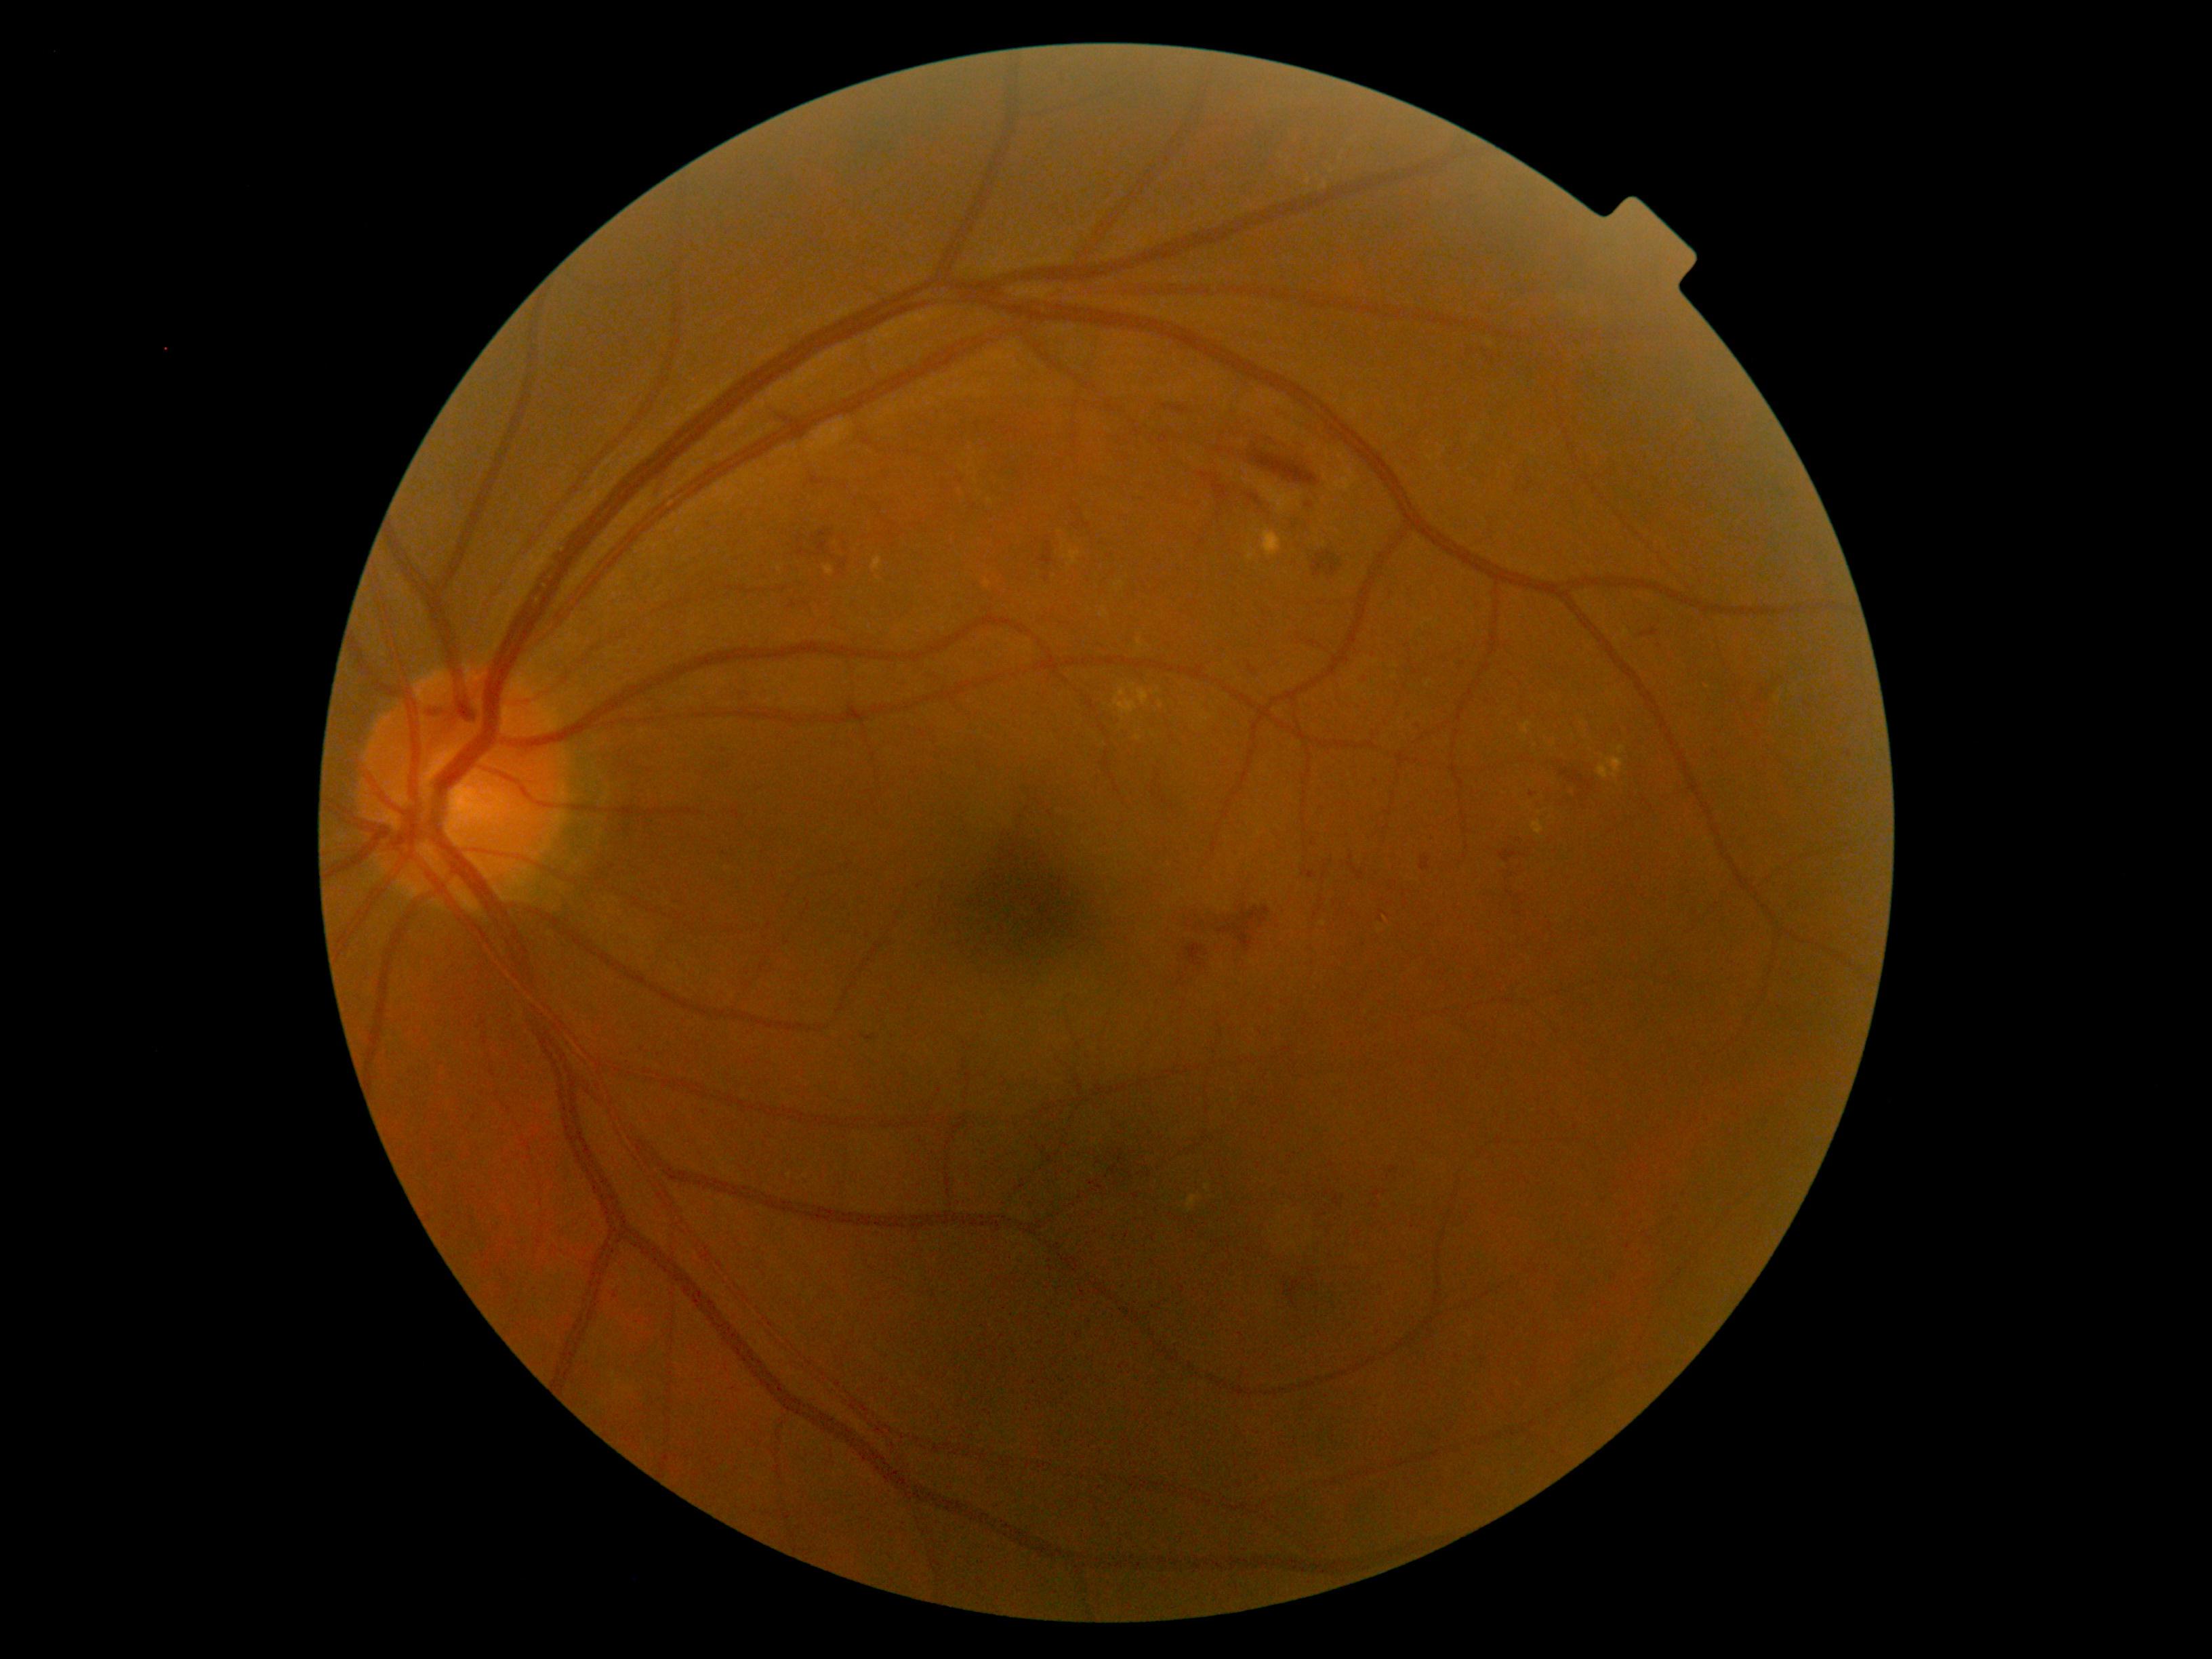
Diabetic retinopathy (DR) is grade 2
Lesions identified (partial list):
hard exudates (EXs) = (1261, 528, 1282, 558); (823, 566, 834, 577); (1113, 689, 1138, 716); (1618, 746, 1626, 754); (1138, 689, 1149, 705); (1523, 723, 1531, 735); (1188, 1196, 1199, 1212); (1531, 821, 1543, 836); (1246, 552, 1257, 560); (1597, 758, 1624, 780); (871, 558, 882, 571)
Smaller EXs around <point>1132, 686</point>; <point>1207, 1188</point>; <point>1156, 693</point>; <point>779, 570</point>; <point>1708, 687</point>; <point>1138, 738</point>
hemorrhages (HEs) (more not shown) = (1187, 944, 1204, 966); (1291, 521, 1311, 535); (1313, 551, 1341, 578); (1760, 684, 1765, 697); (813, 541, 829, 558); (1498, 851, 1517, 863); (1249, 449, 1319, 487); (1225, 917, 1234, 924); (1290, 1280, 1302, 1295); (1216, 907, 1271, 952); (1164, 405, 1191, 414); (1238, 490, 1269, 509); (1559, 771, 1595, 792); (813, 529, 834, 540); (1039, 541, 1055, 566)
Smaller HEs around <point>1218, 923</point>
microaneurysms (MAs) (more not shown) = (1420, 857, 1429, 871); (1249, 665, 1257, 674); (1306, 871, 1314, 882); (1650, 626, 1658, 635)
Smaller MAs around <point>616, 1296</point>; <point>1314, 843</point>; <point>1419, 727</point>; <point>1309, 506</point>; <point>1376, 781</point>; <point>1533, 795</point>; <point>1393, 1169</point>
soft exudates (SEs) = not present